DR severity per modified Davis staging. No pharmacologic dilation:
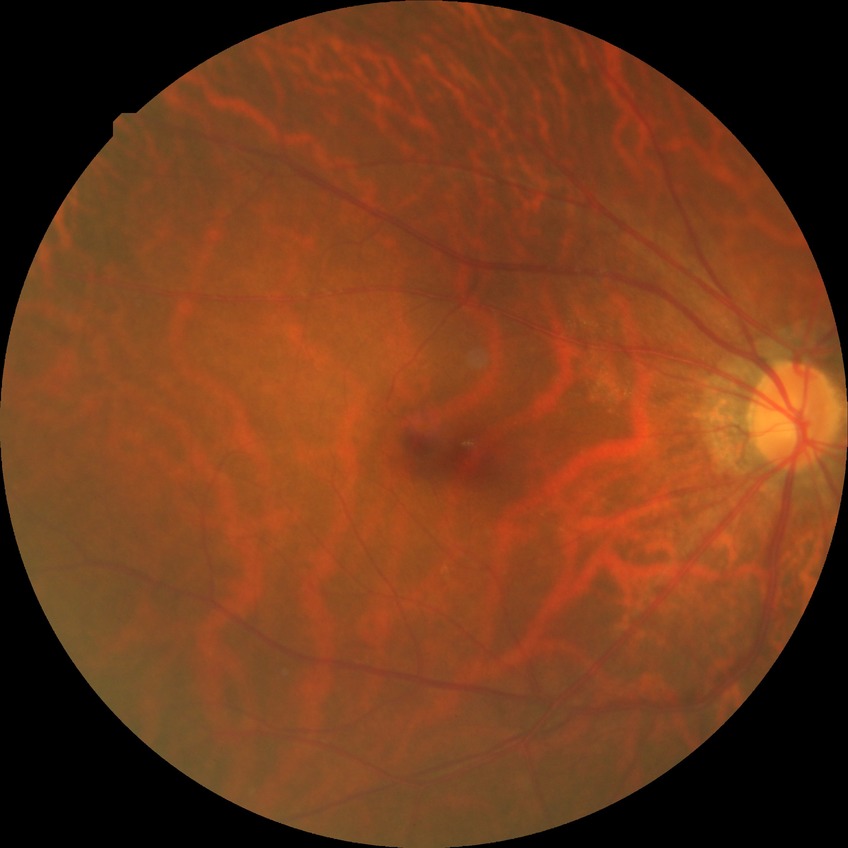 Diabetic retinopathy (DR): NDR (no diabetic retinopathy).